CFP: 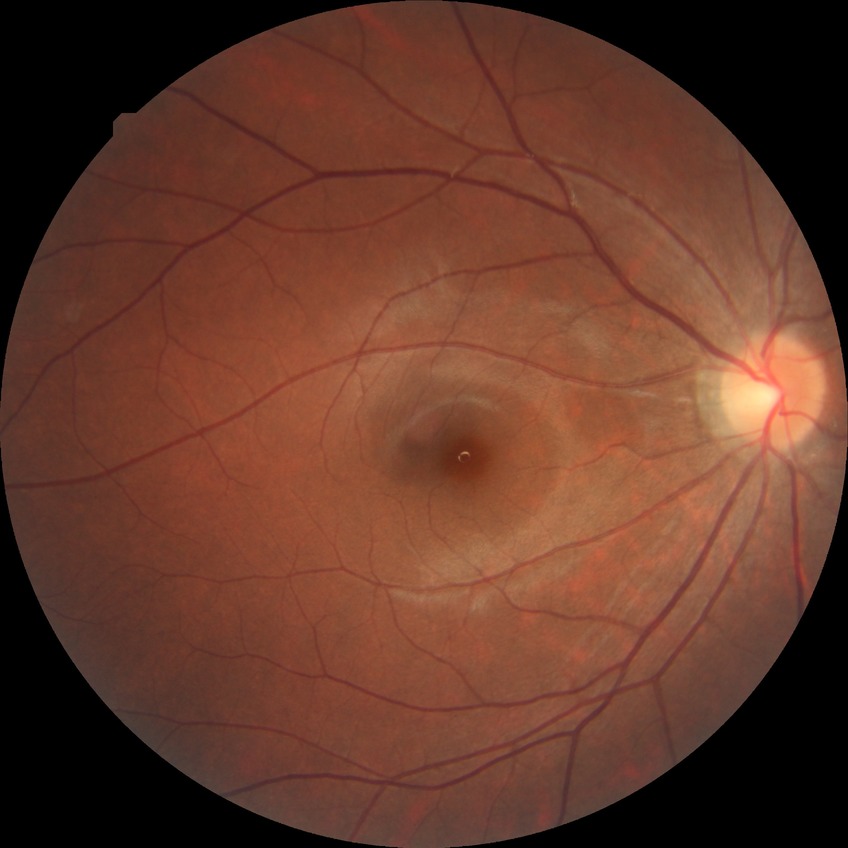

{"davis_grade": "simple diabetic retinopathy (SDR)"}